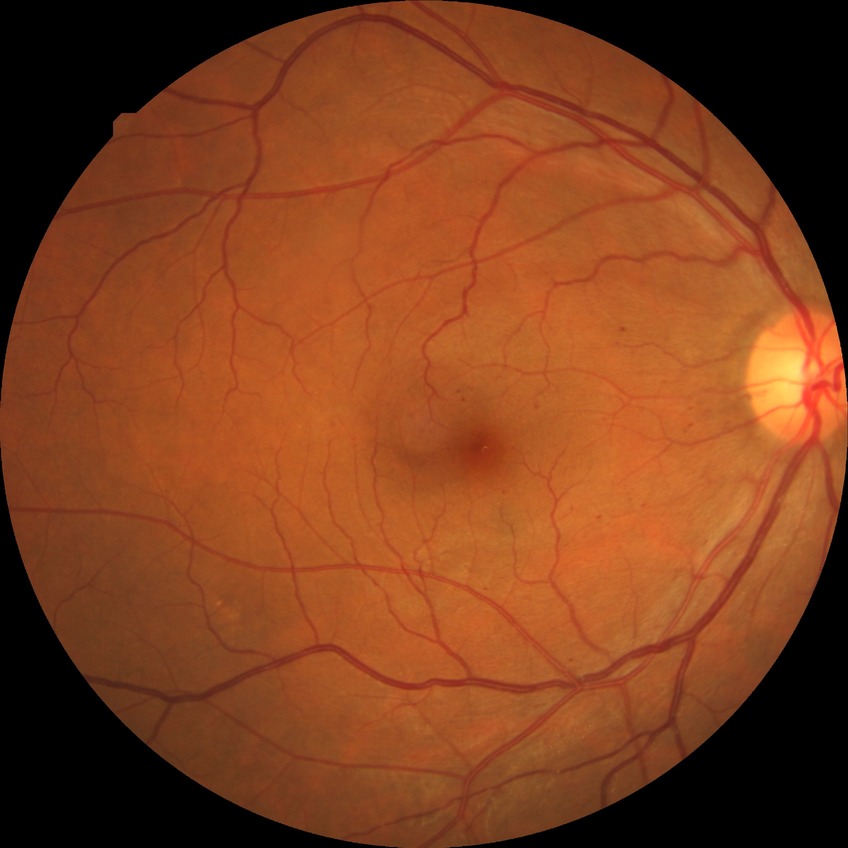
The retinopathy is classified as non-proliferative diabetic retinopathy. Davis grading is simple diabetic retinopathy.